Image size 848x848; Davis DR grading; 45° field of view — 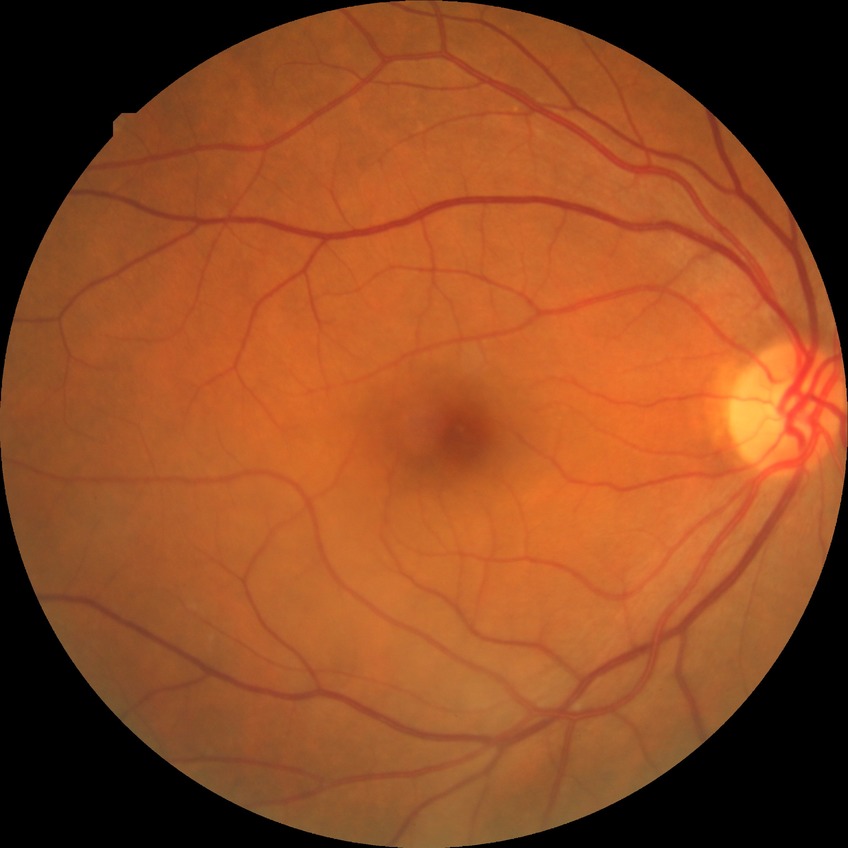 Diabetic retinopathy (DR): NDR (no diabetic retinopathy).